Image size 1924x1556. Ultra-widefield (UWF) fundus image. 200° field of view
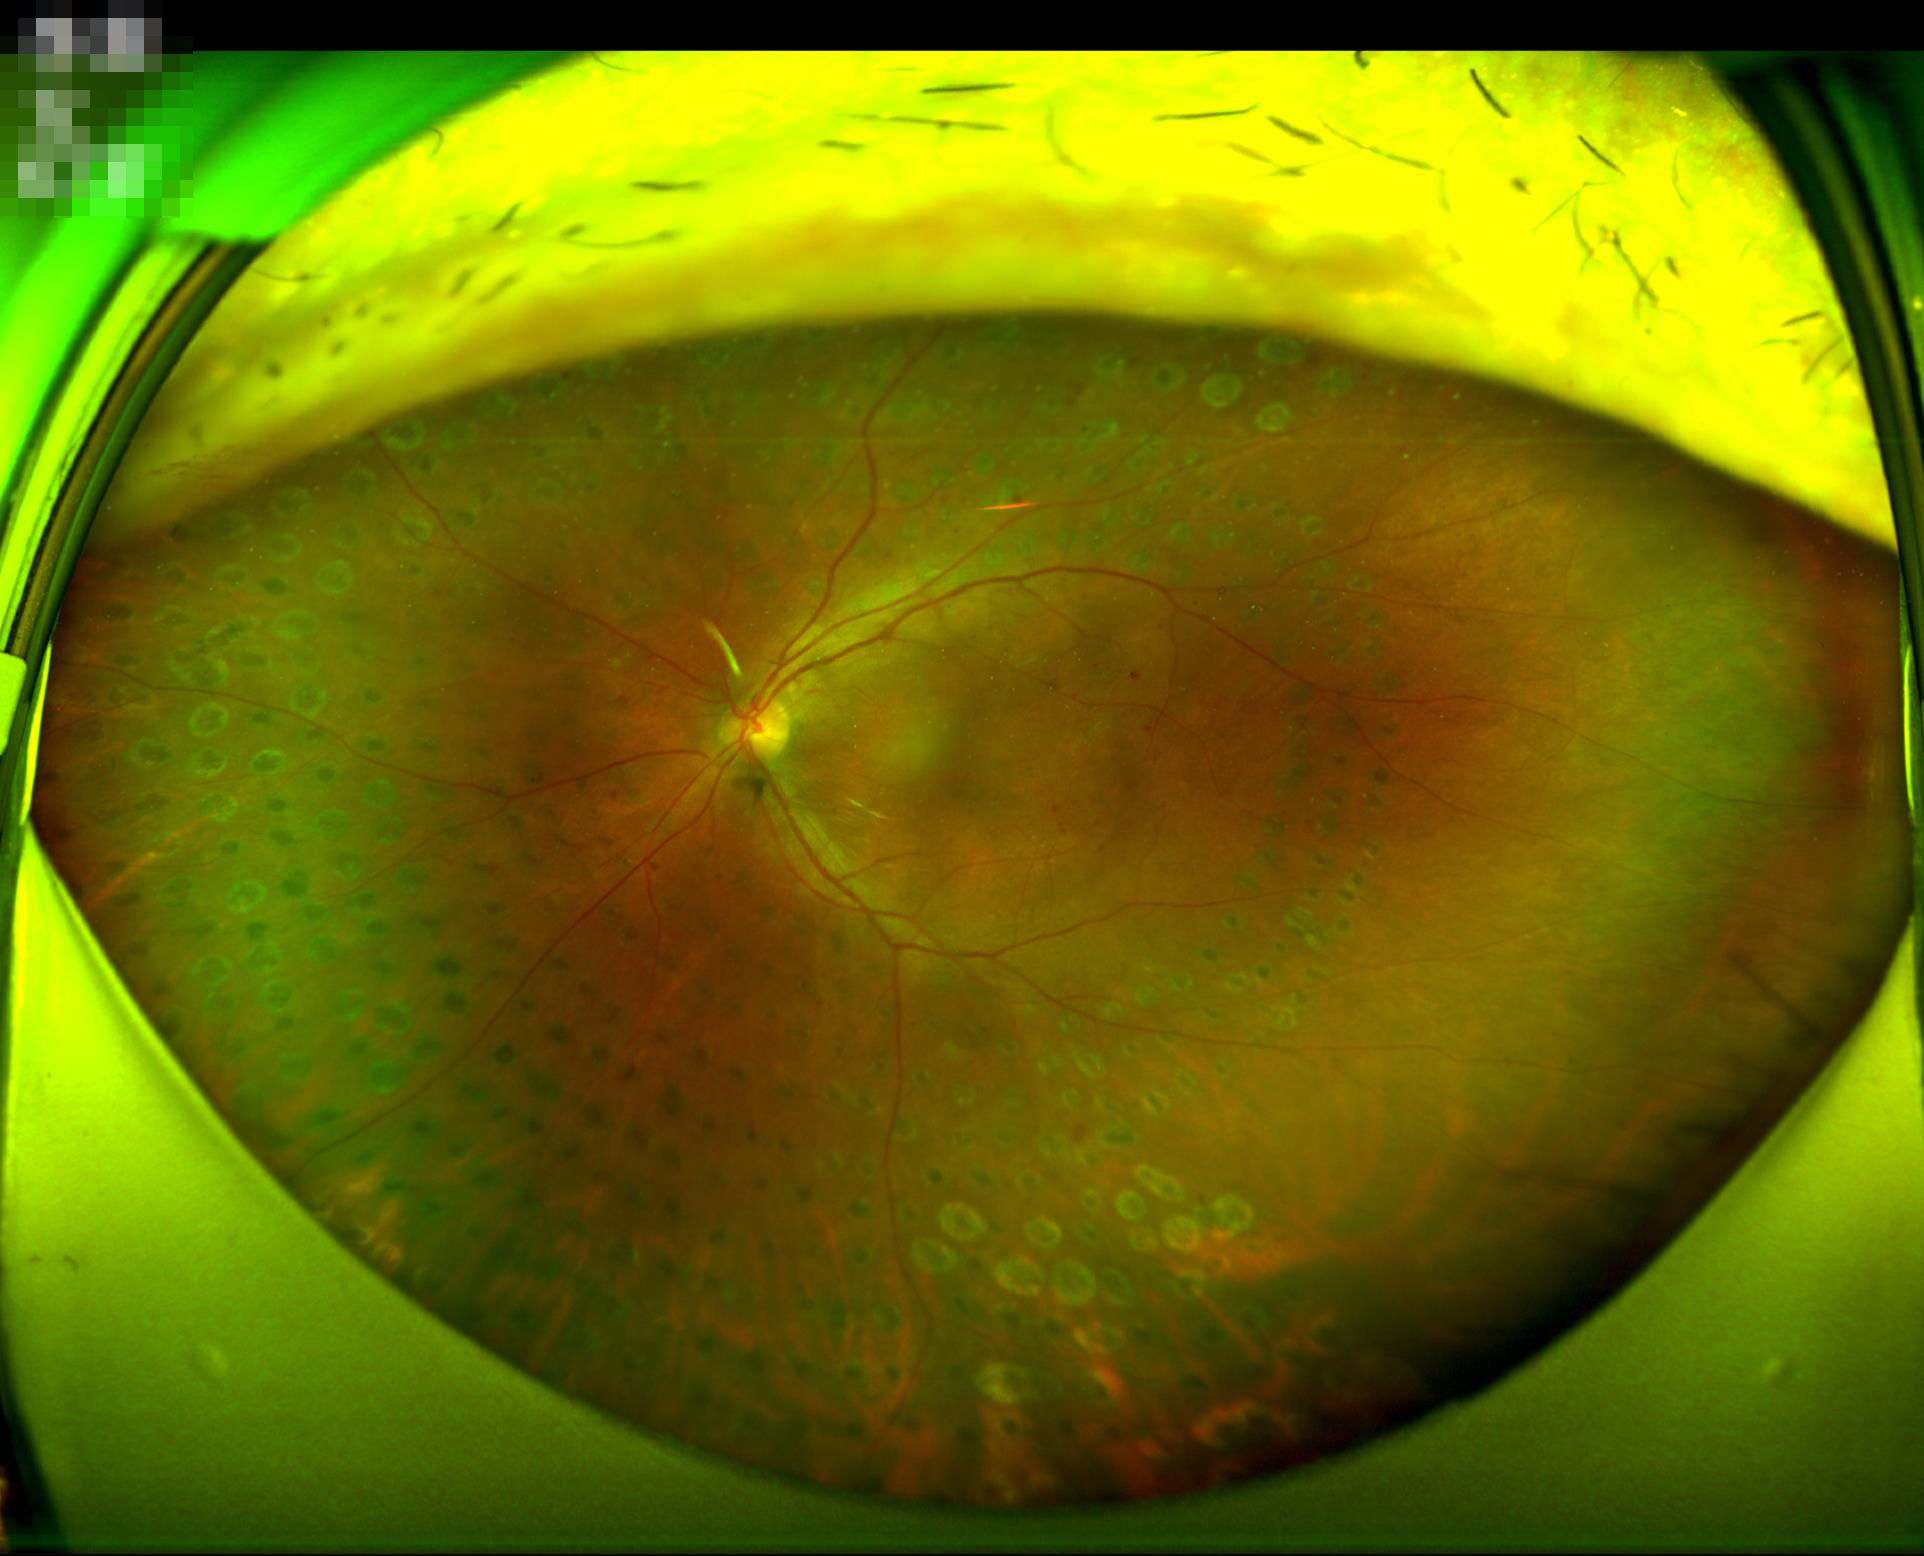

Quality grading: overall: good and suitable for diagnostic use; sharpness: optic disc, vessels, and background in focus; illumination/color: no over- or under-exposure.